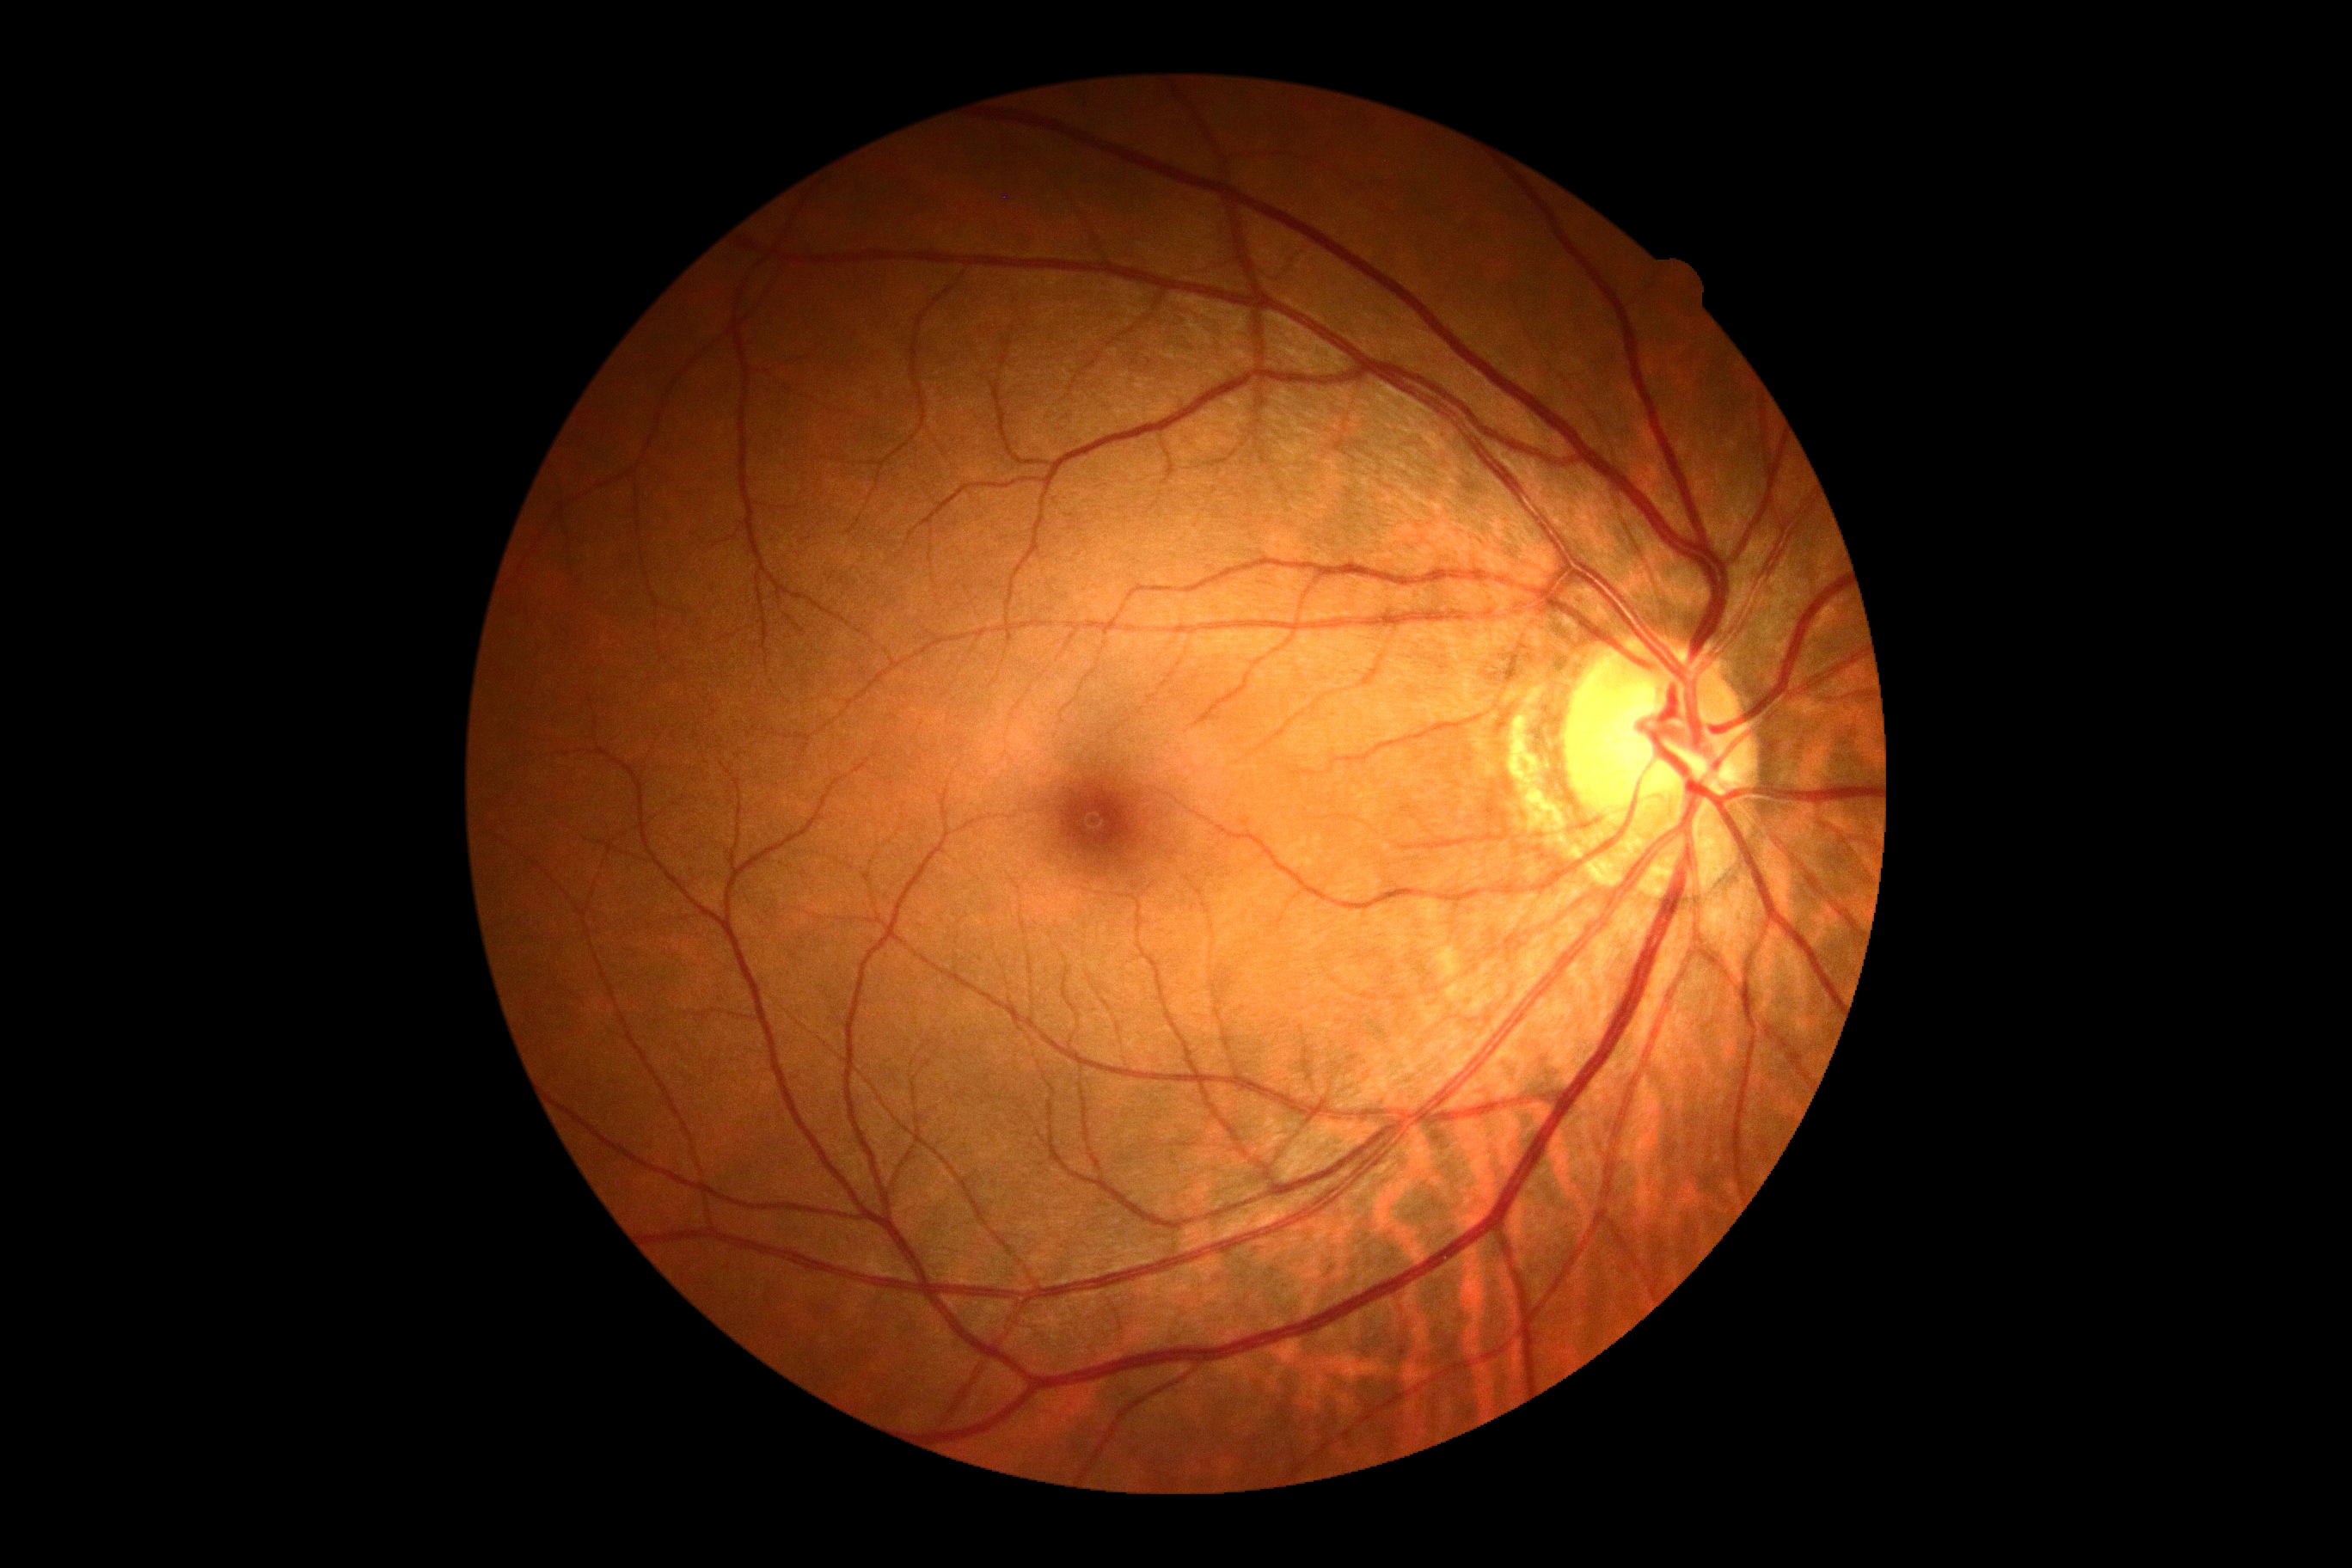
retinopathy: 0.